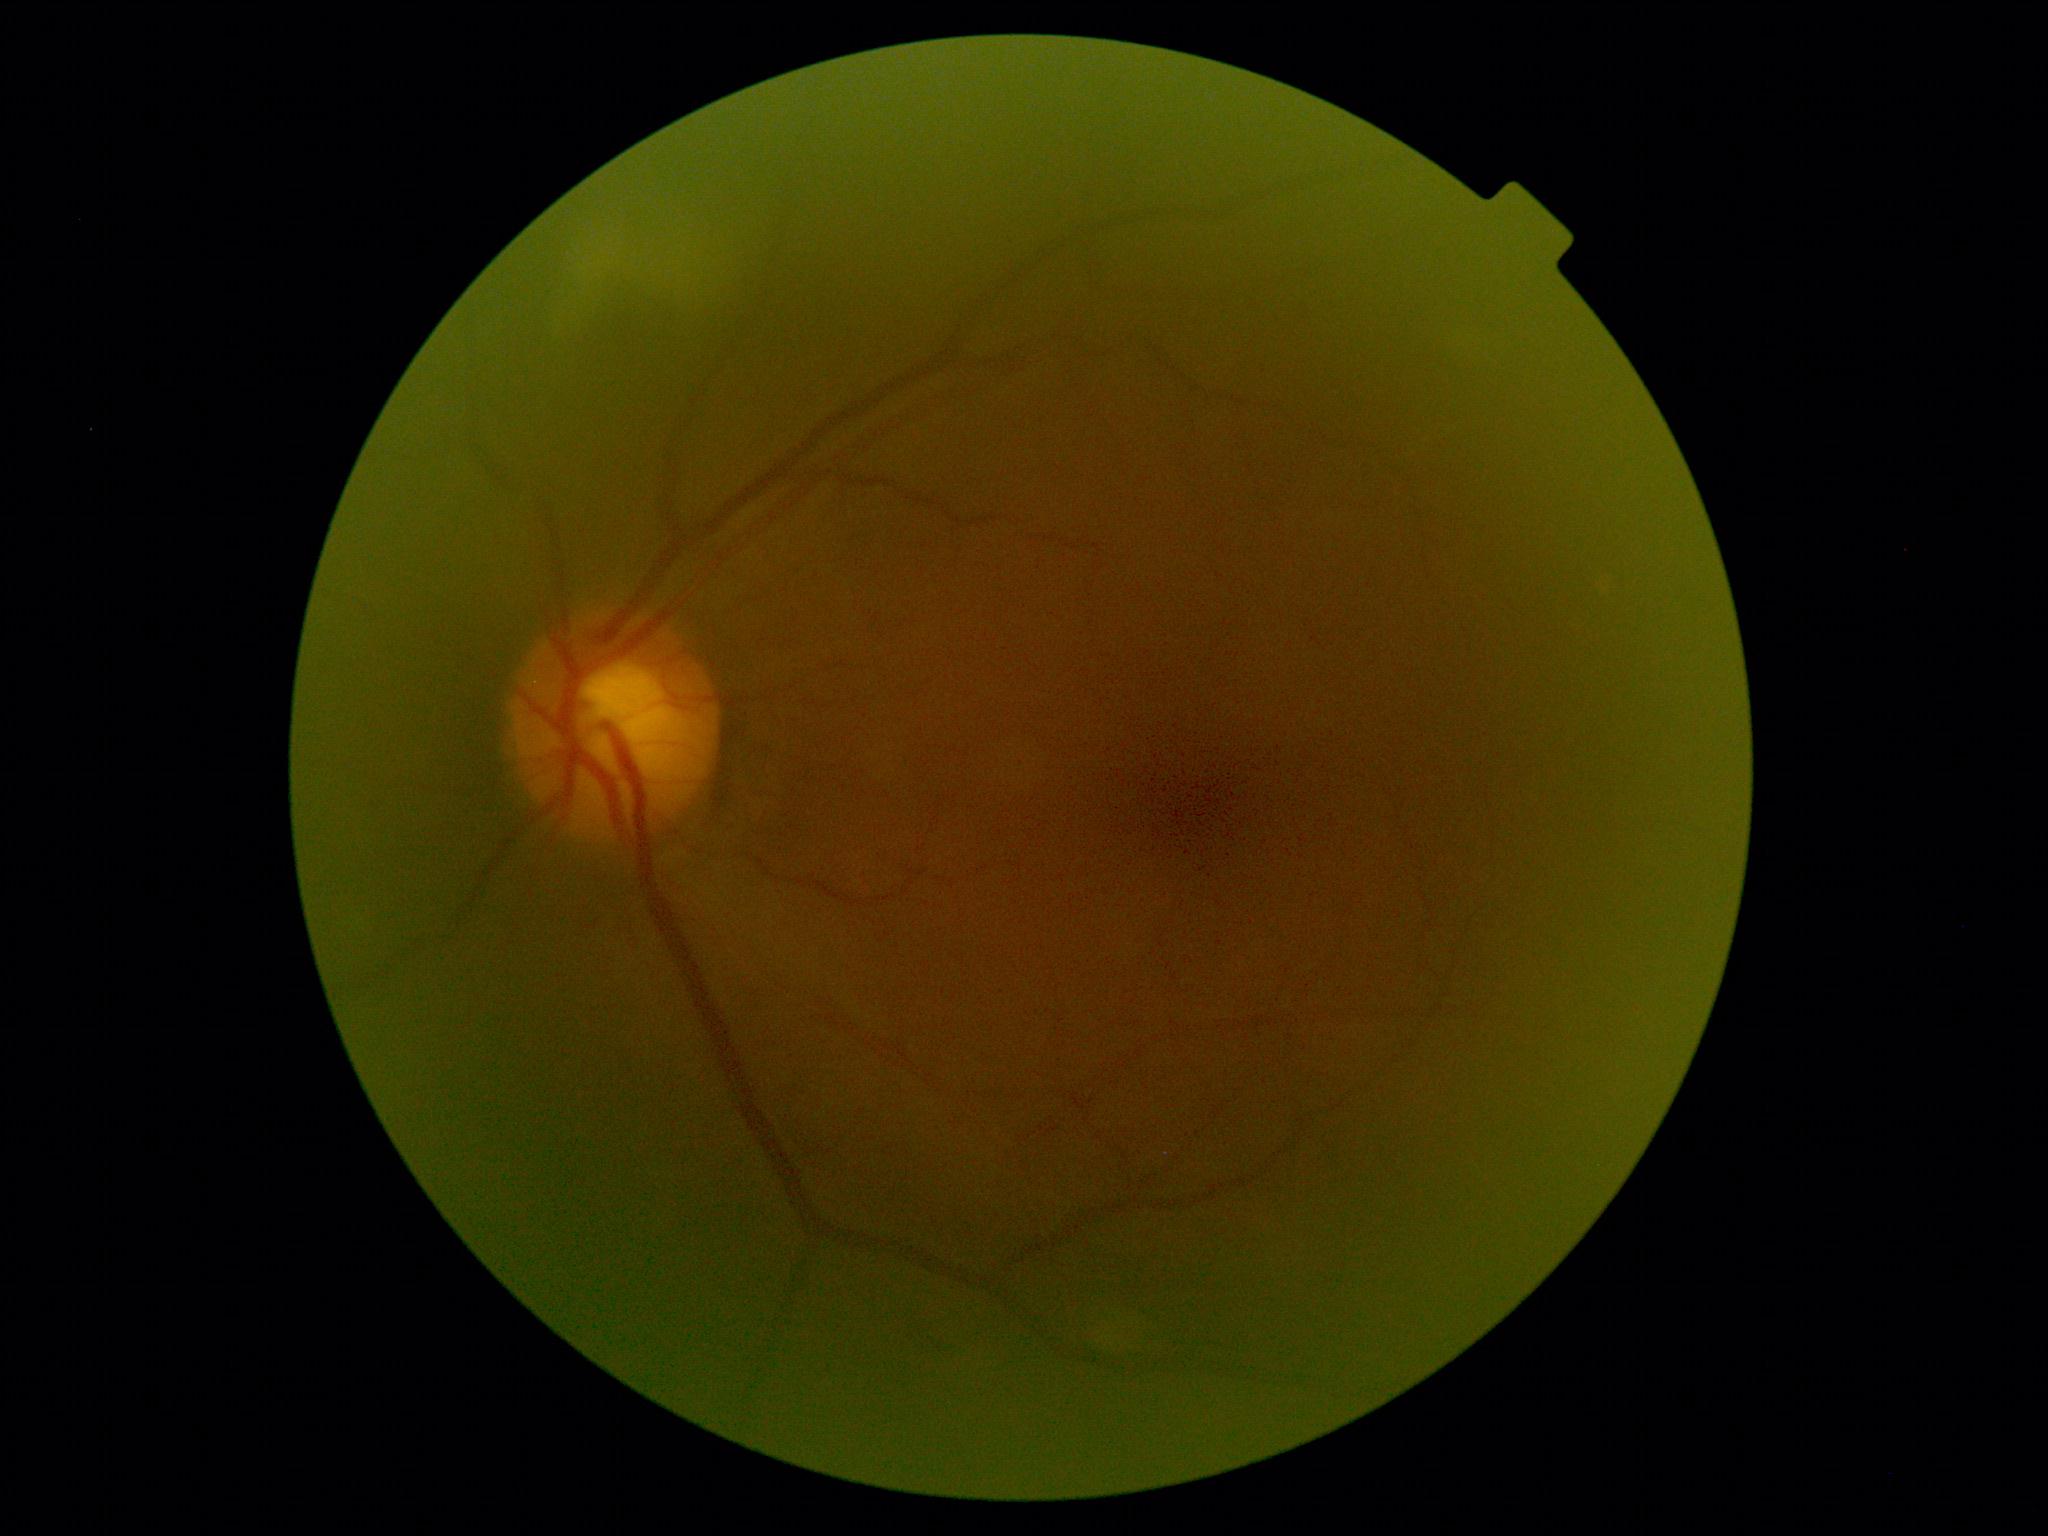
diabetic retinopathy: grade 2 (moderate NPDR).